Infant wide-field retinal image — 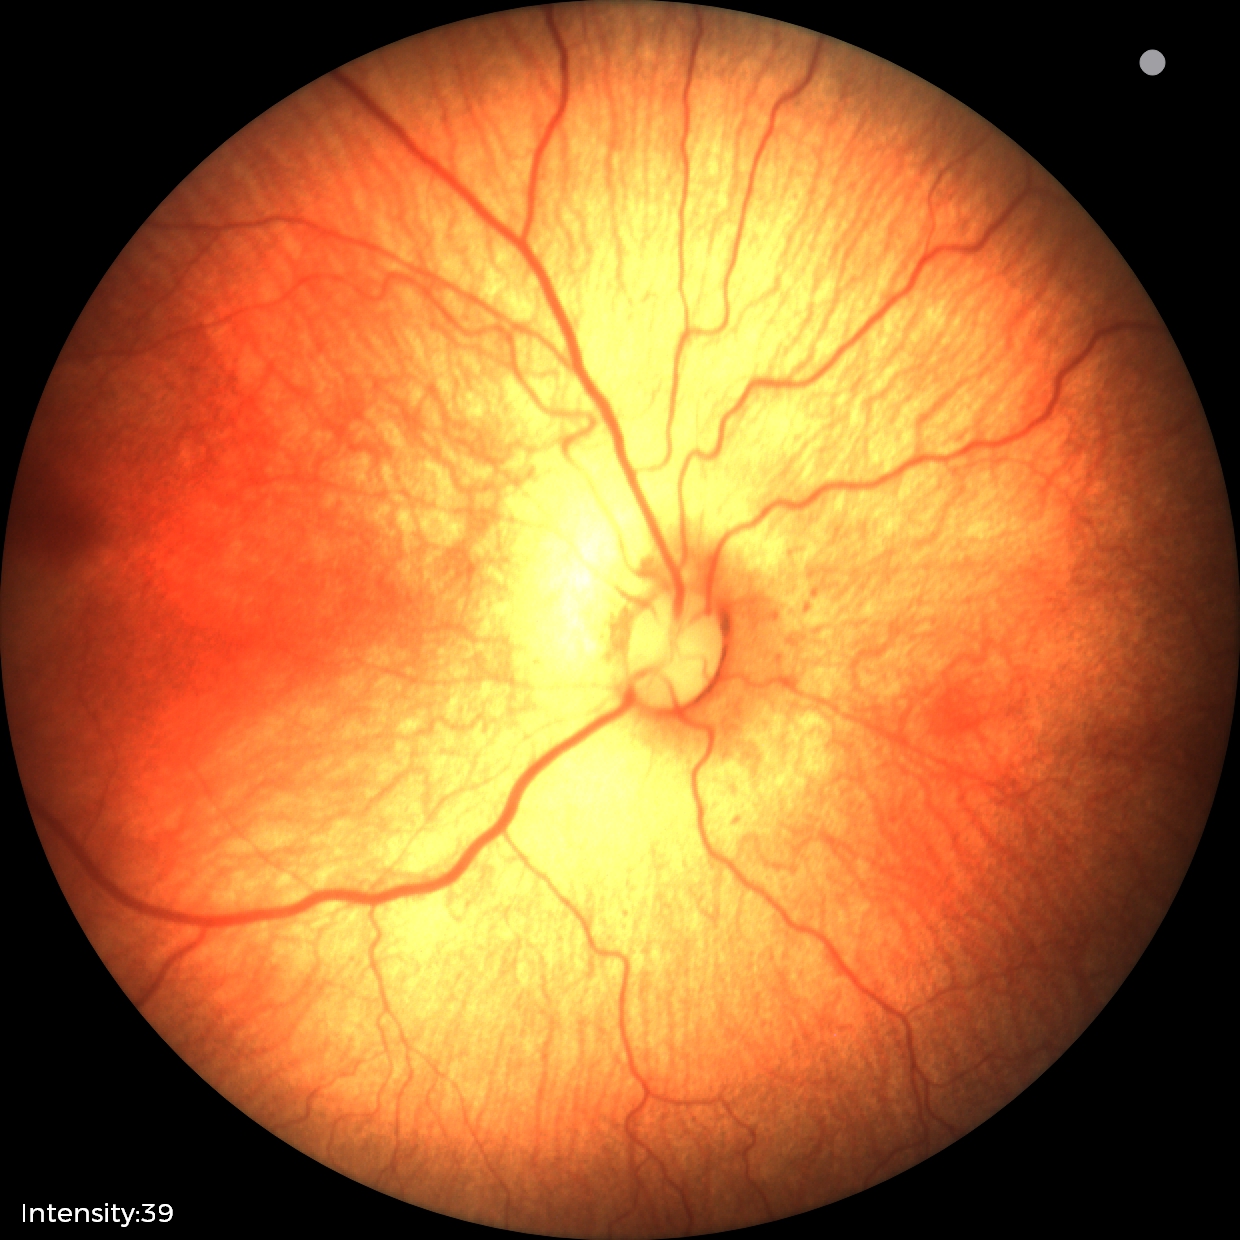 Assessment: status post ROP — retinal appearance after treated retinopathy of prematurity | no plus disease — posterior pole vessels without abnormal dilation or tortuosity.